FOV: 45 degrees.
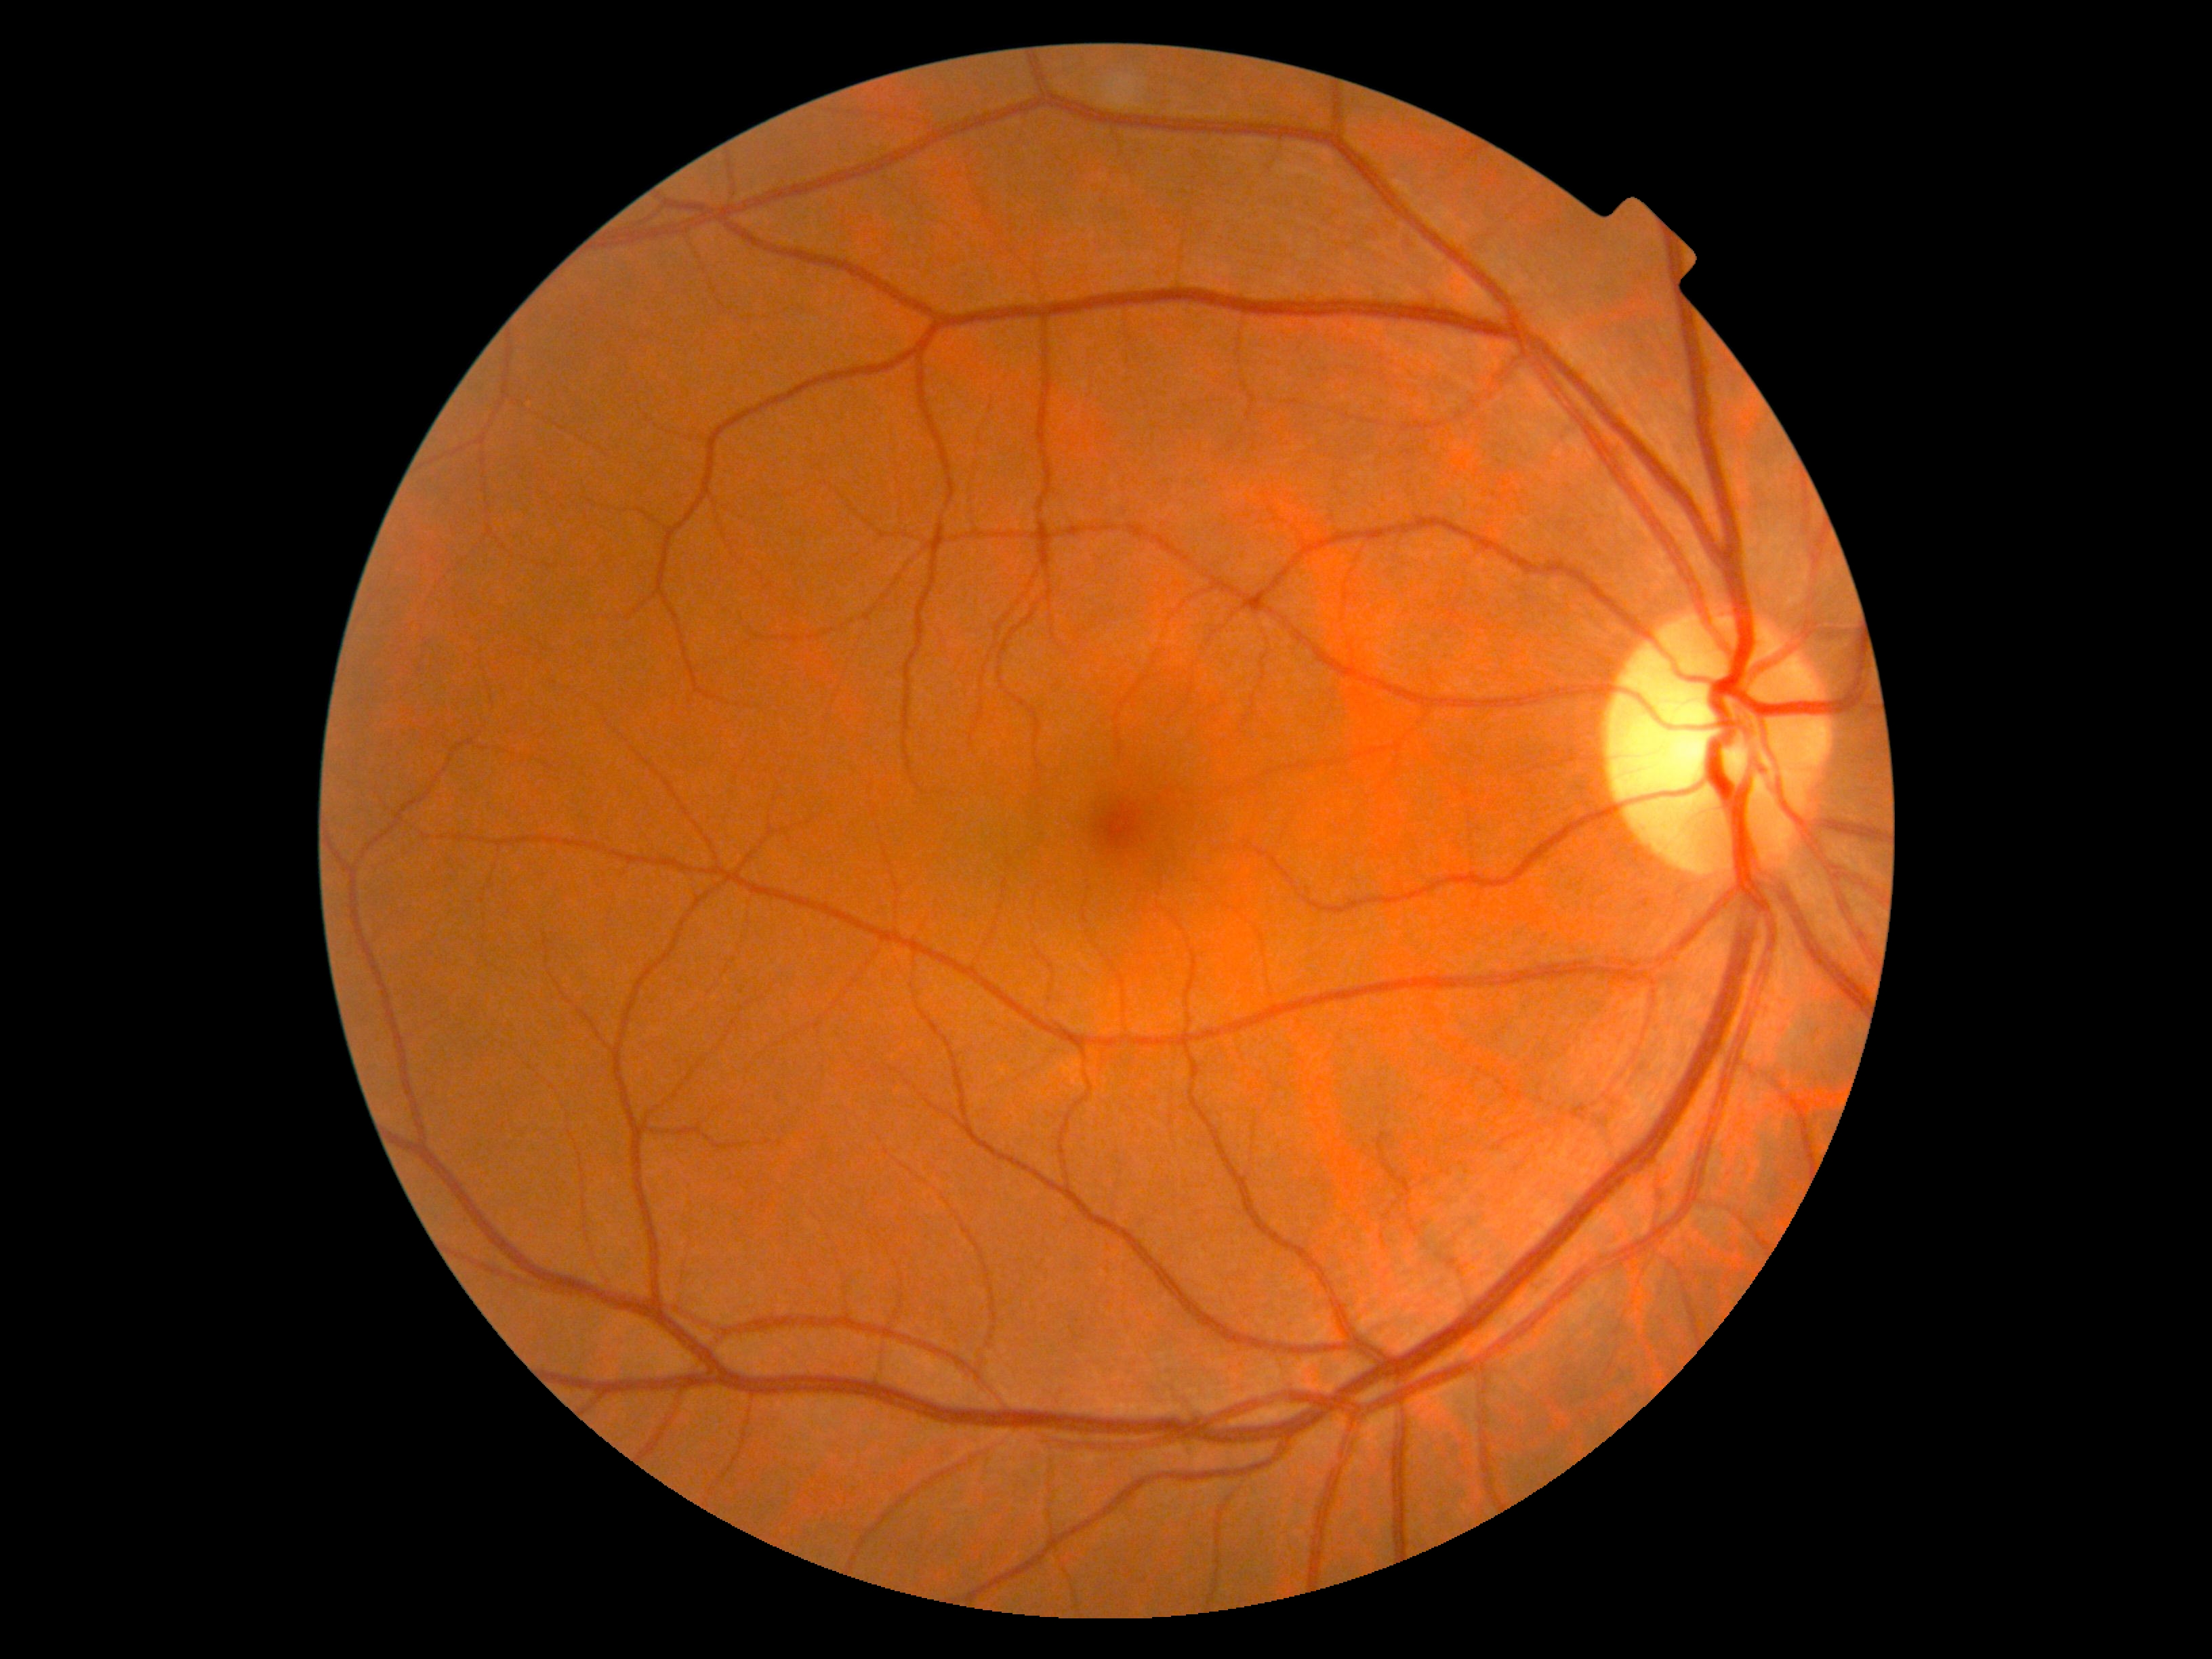

{
  "dr_grade": "grade 0 (no apparent retinopathy)"
}